45° FOV. Image size 412x310. Color fundus photograph — 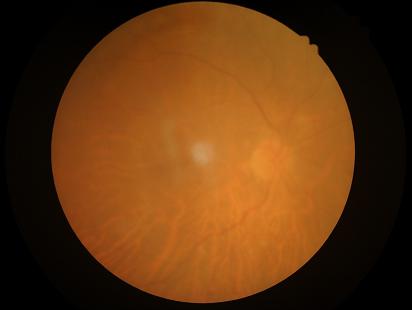
Poor dynamic range.
Illumination and color balance are good.
Noticeable blur in the optic disc, vessels, or background.
Overall image quality is poor.